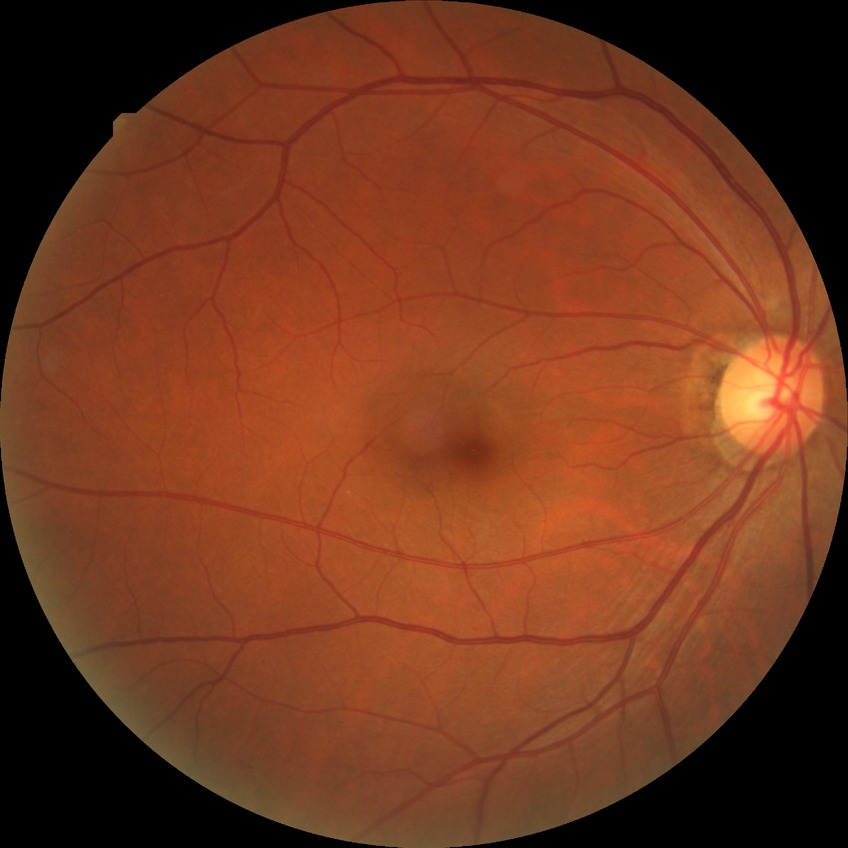
Diabetic retinopathy (DR) is no diabetic retinopathy (NDR).